Graded on the modified Davis scale — 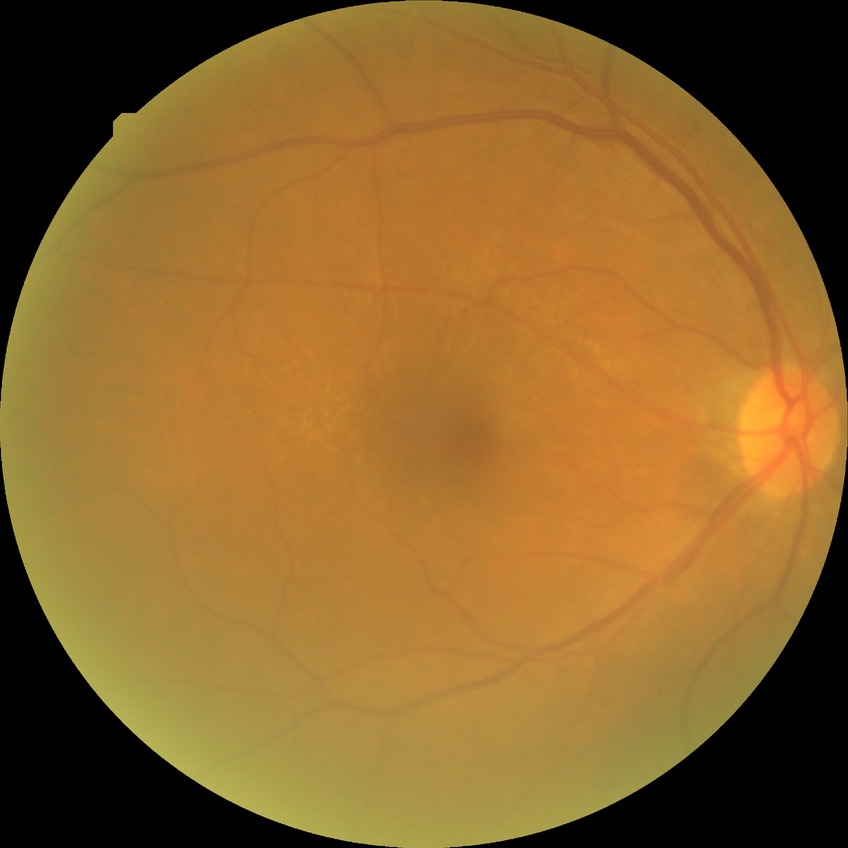
Diabetic retinopathy (DR): no diabetic retinopathy (NDR).